Captured on a Remidio Fundus on Phone:
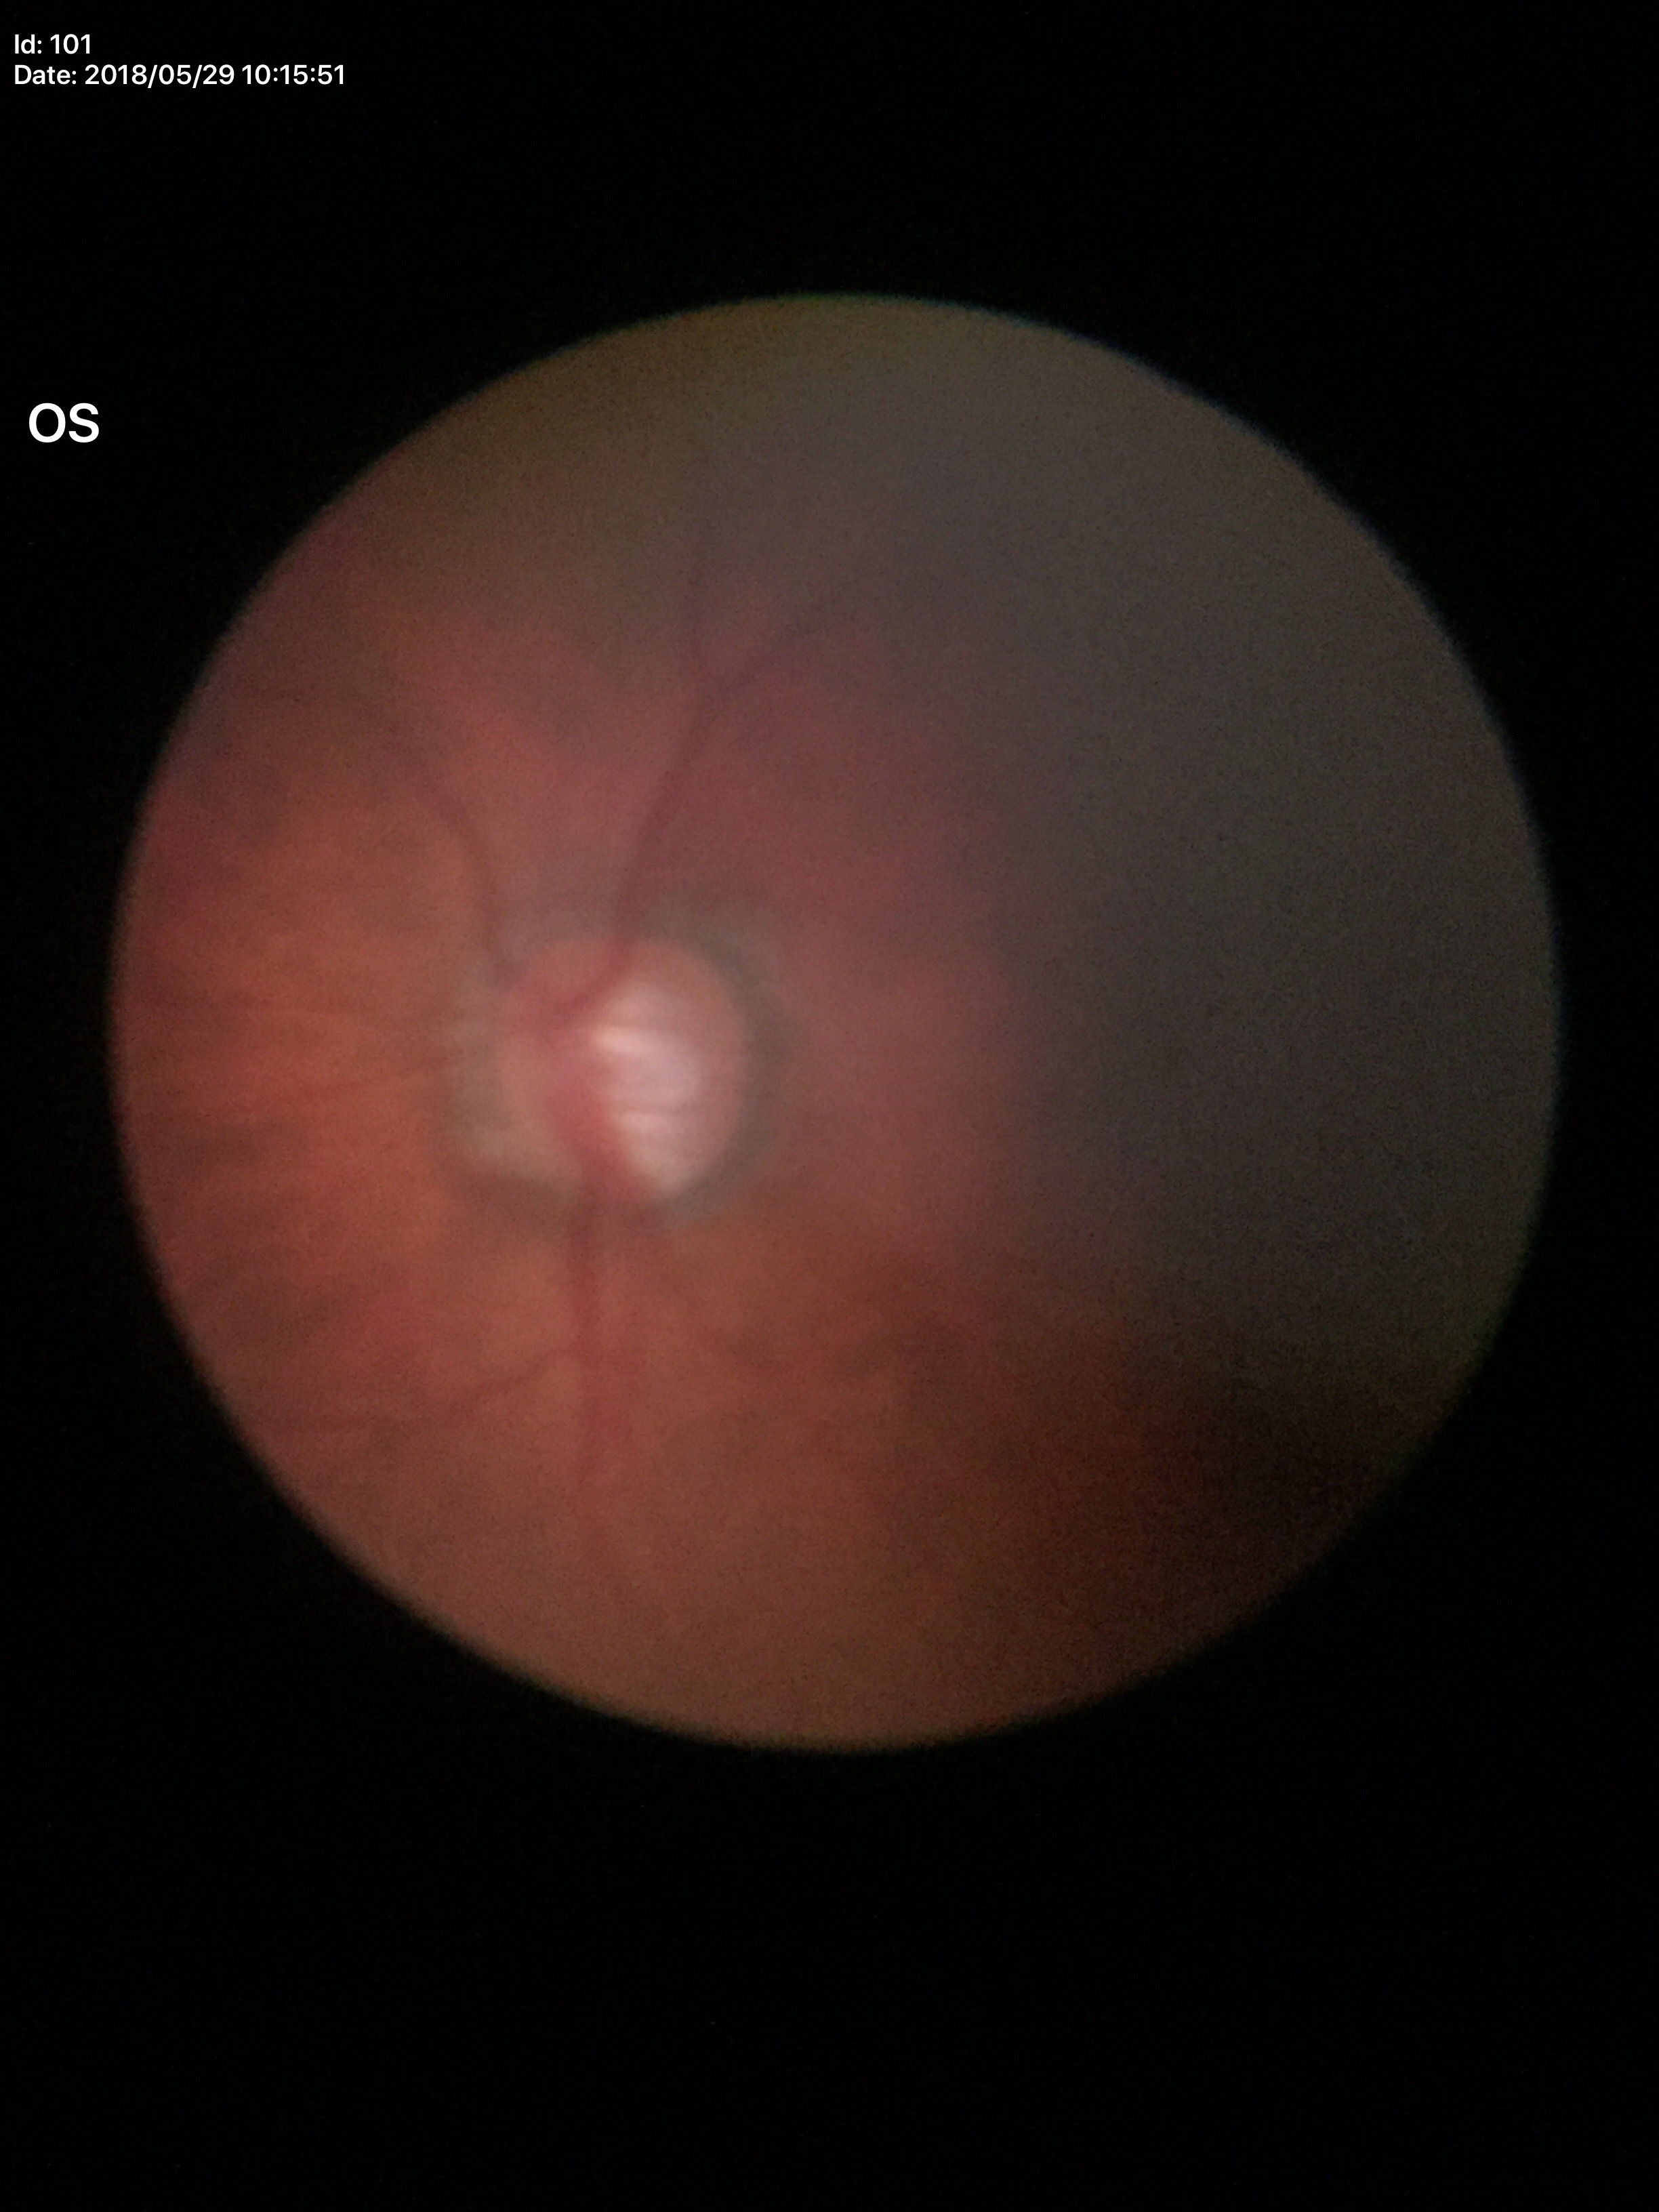 Glaucoma assessment: suspicious. VCDR: 0.76. ACDR: 0.48. HCDR: 0.64.